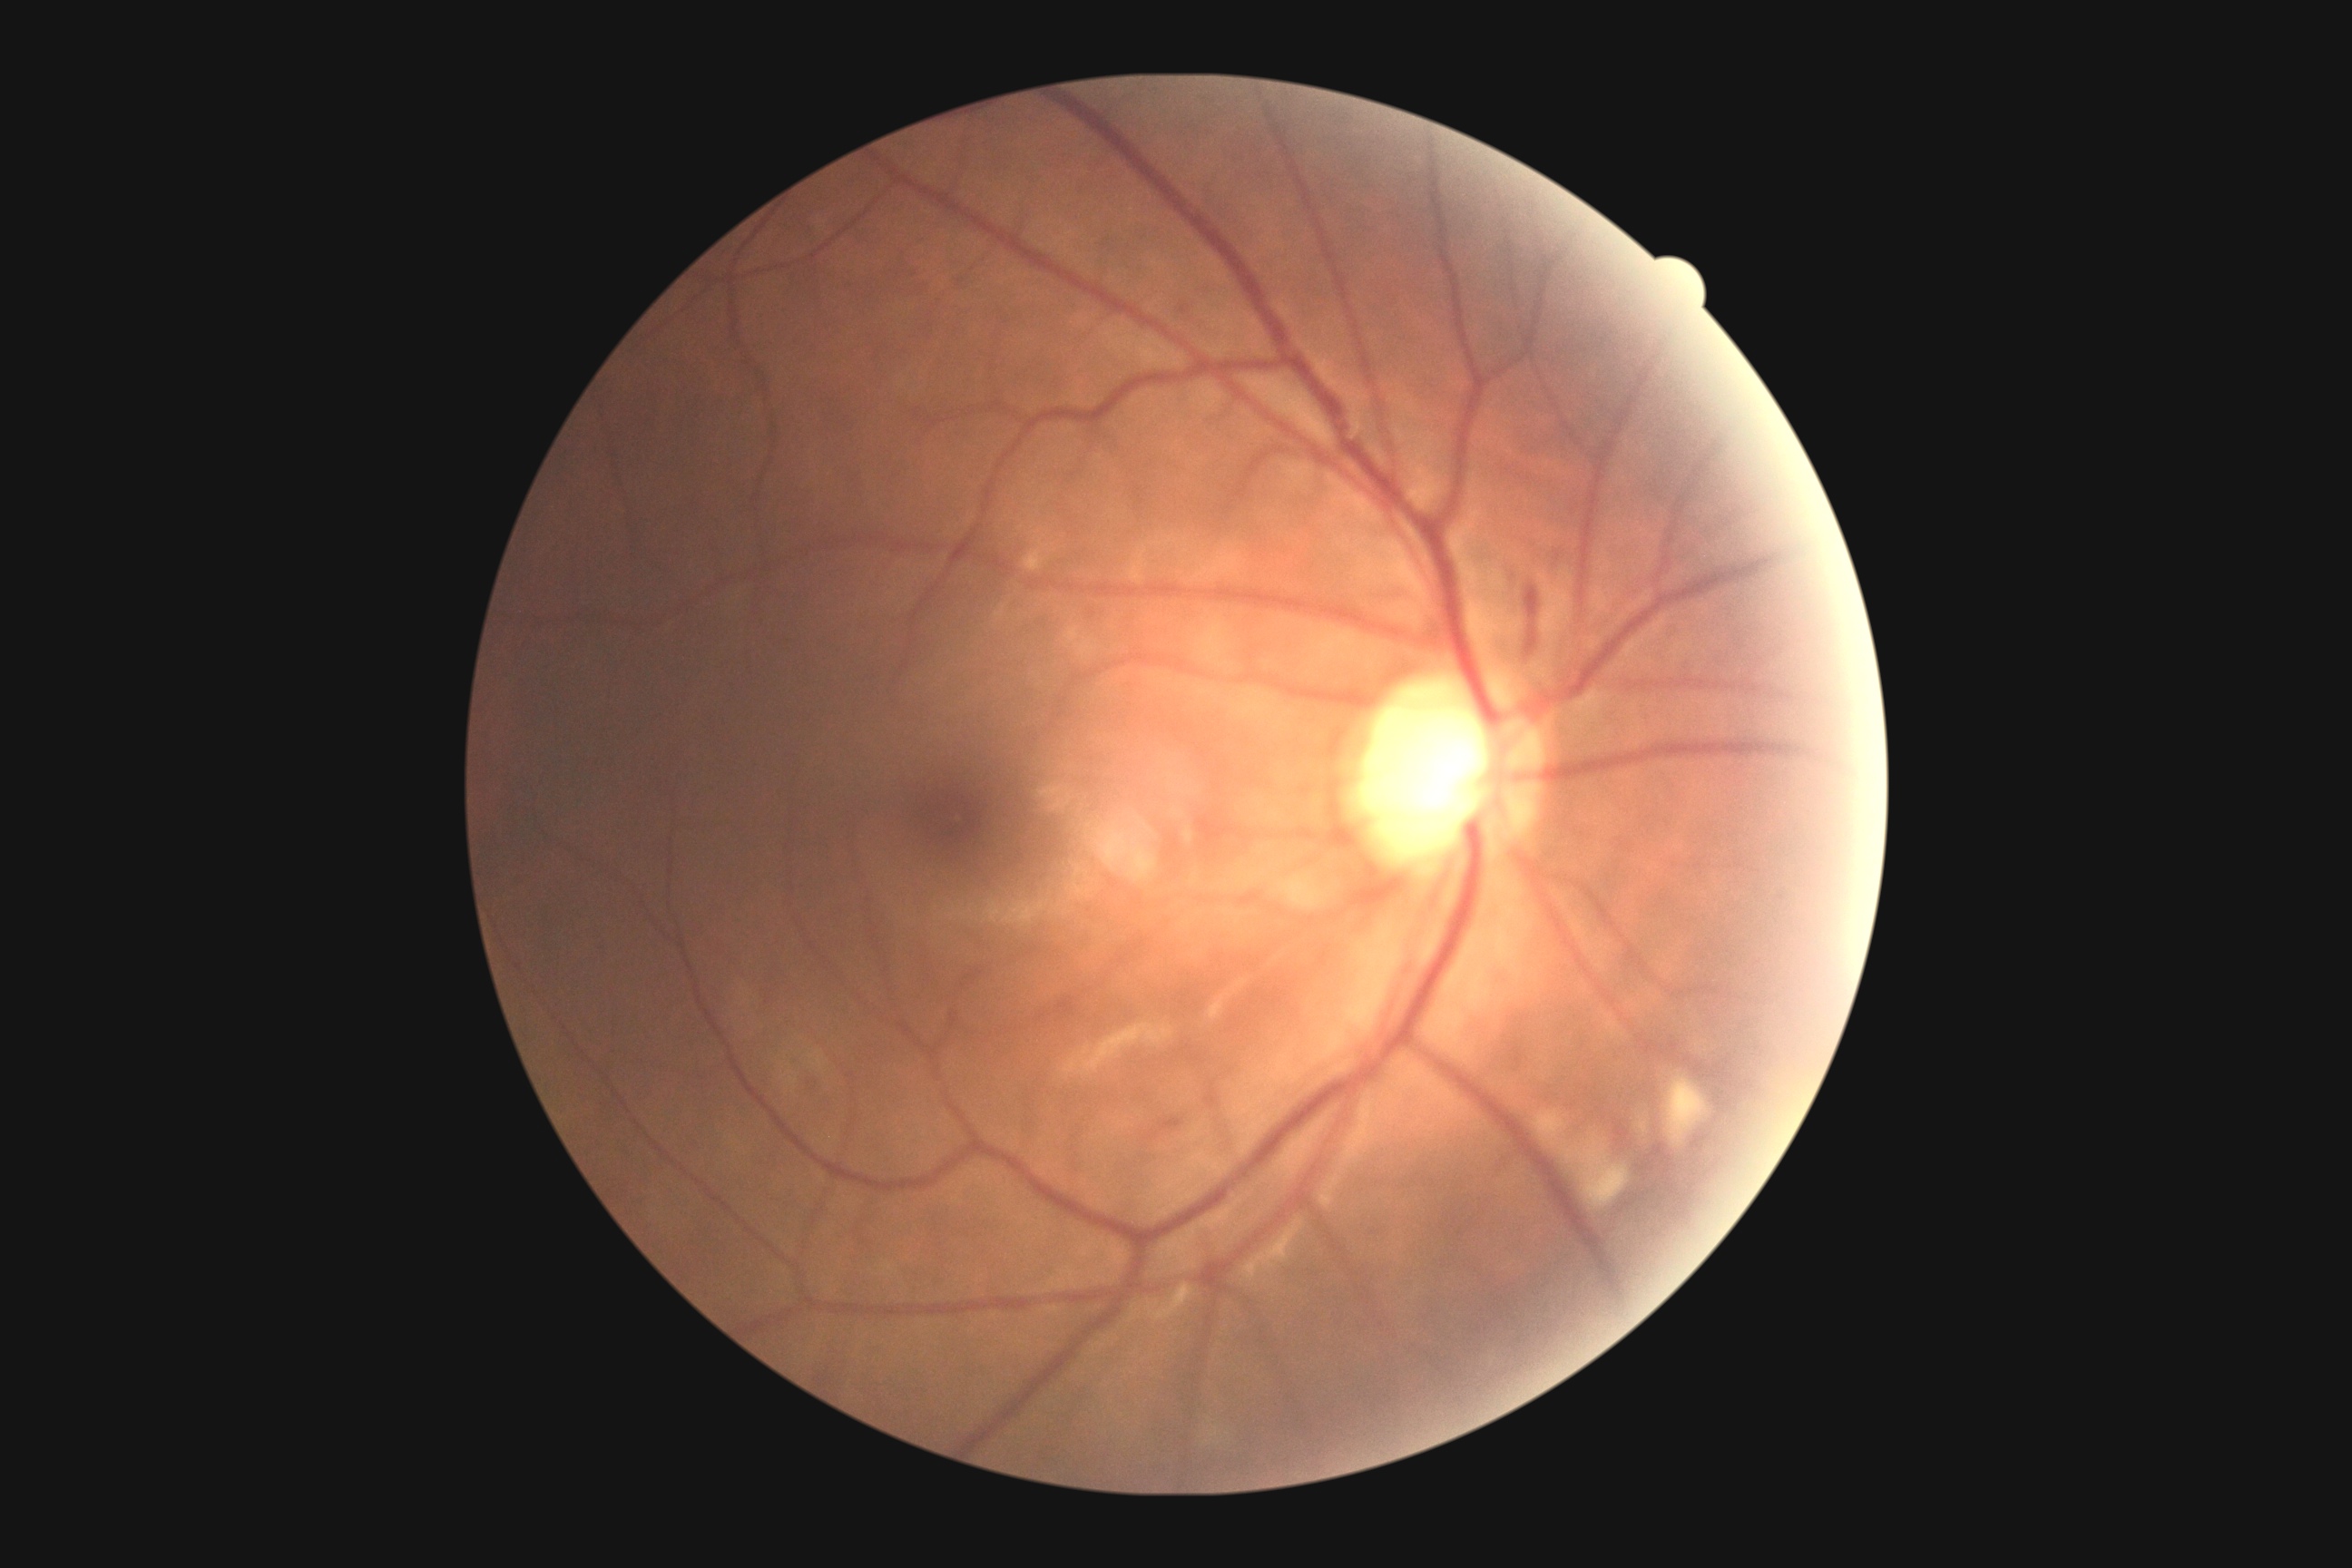
Diabetic retinopathy: grade 2 (moderate NPDR).